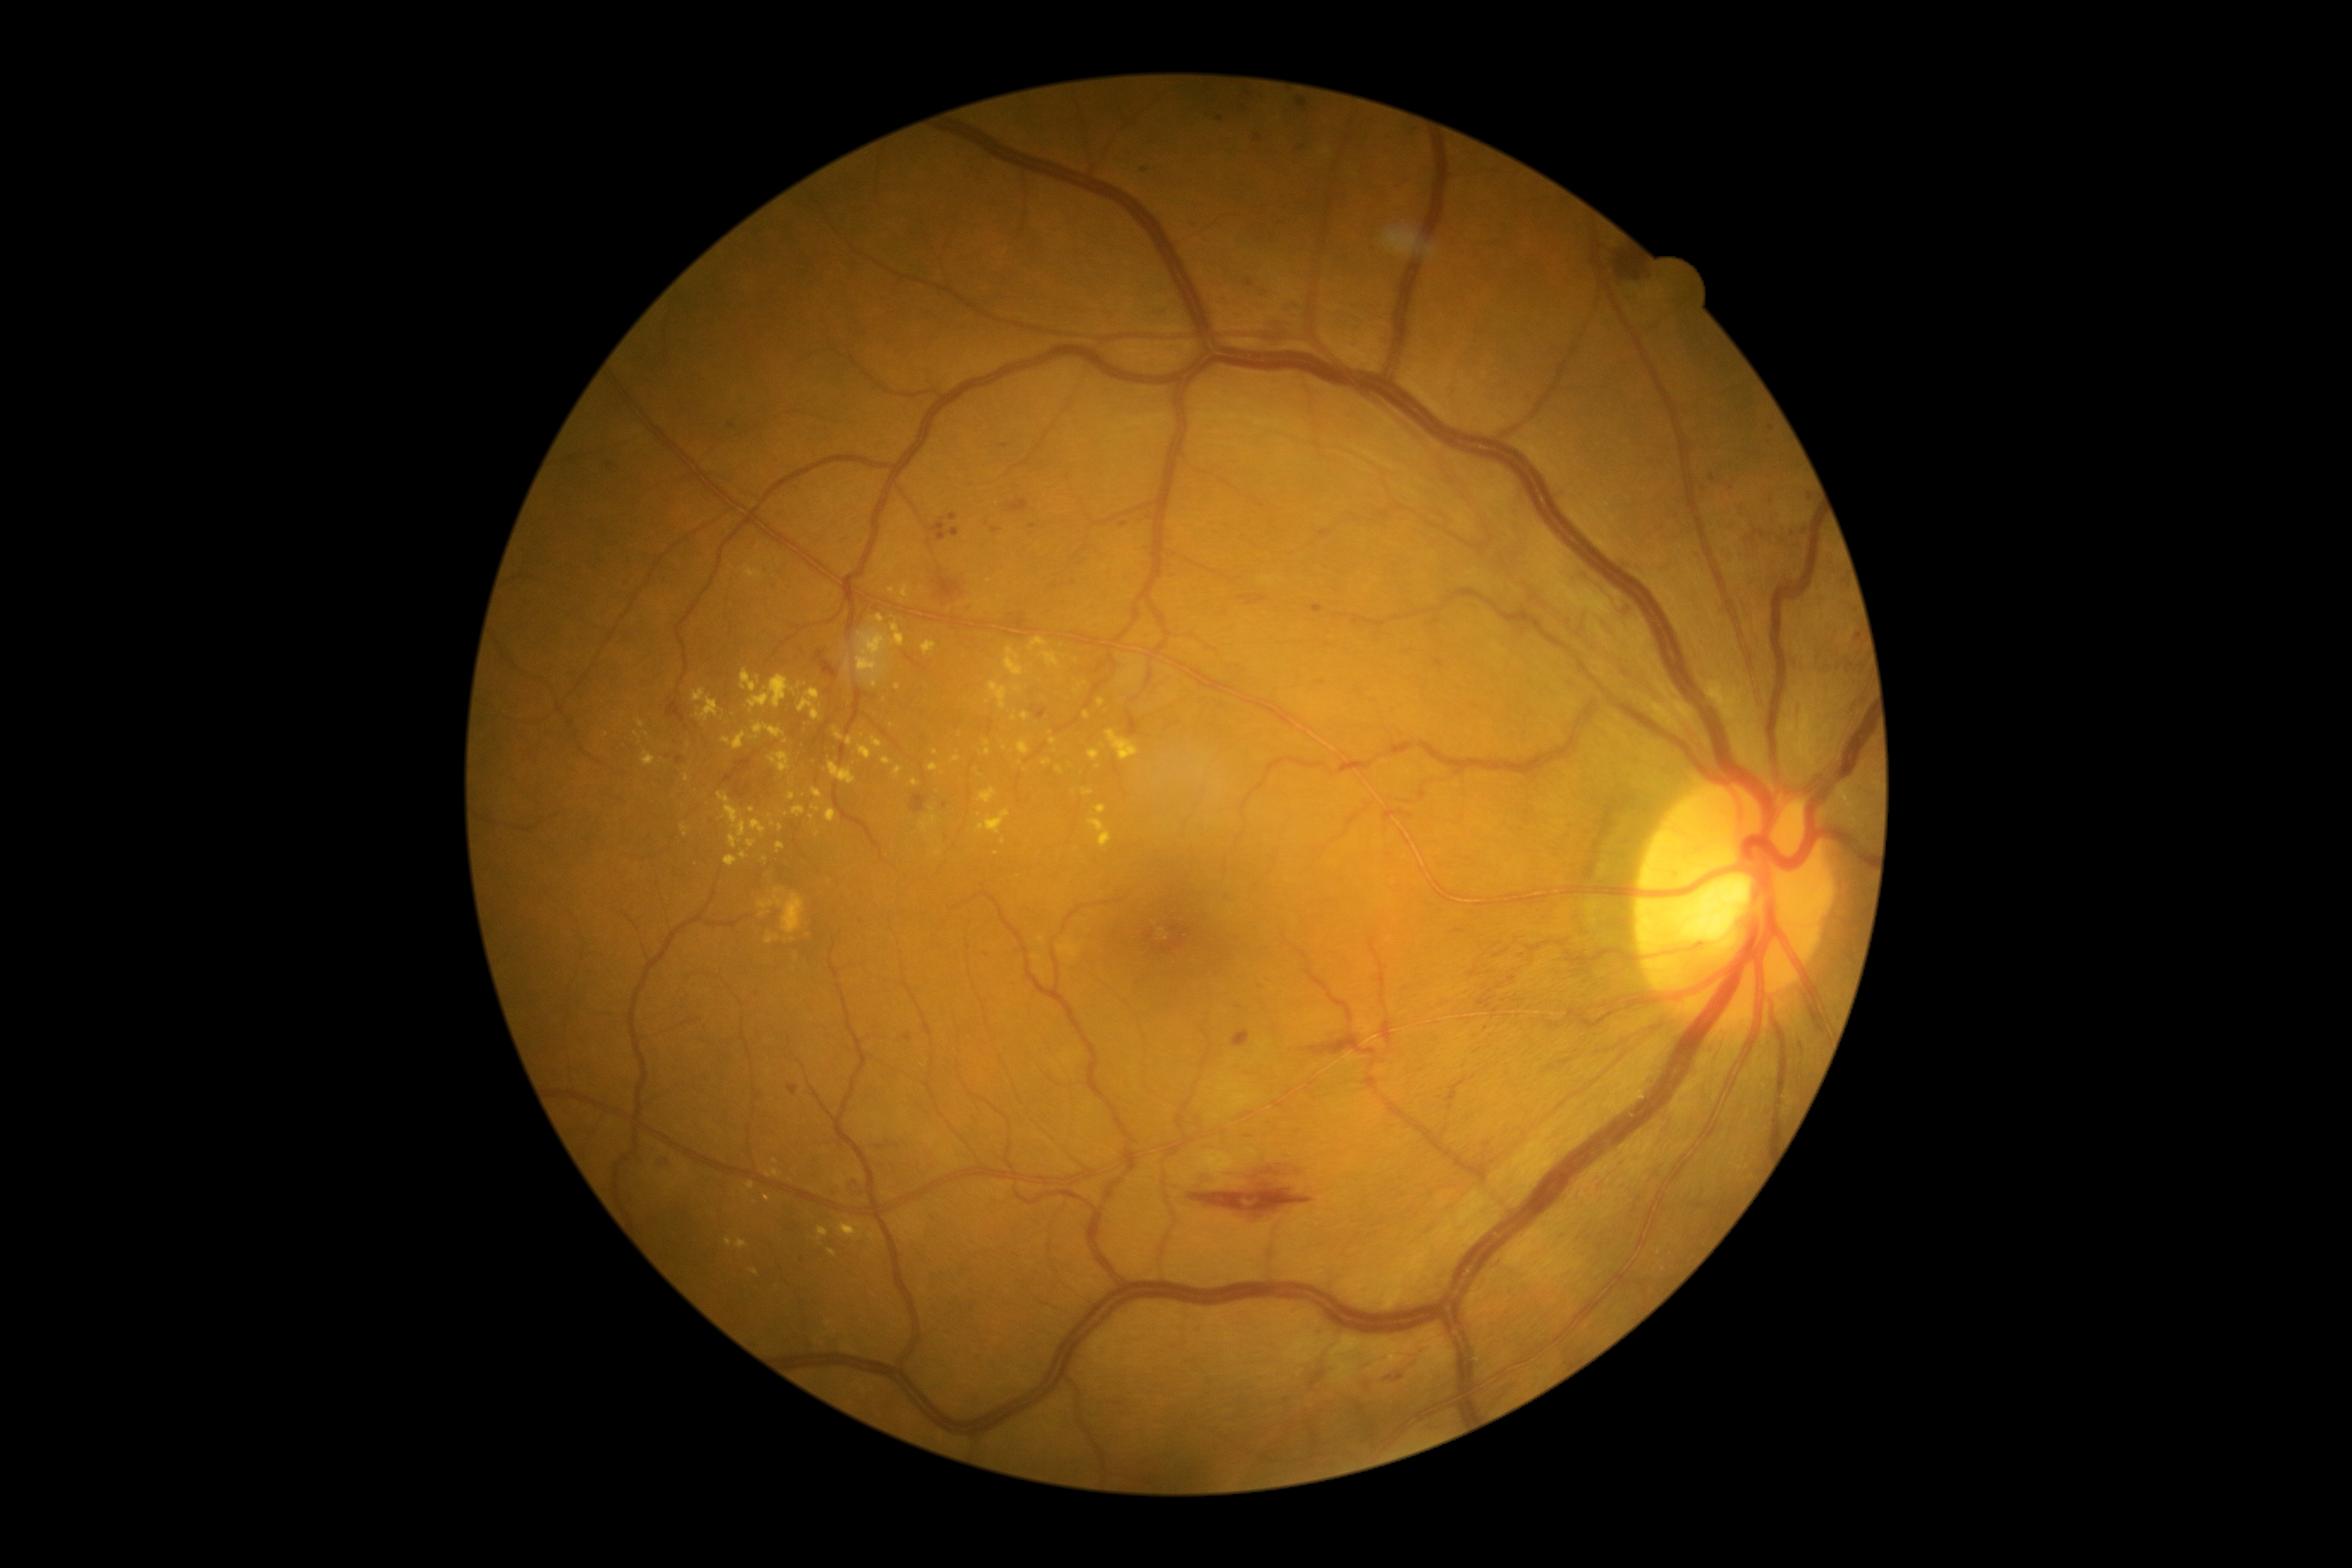
Retinopathy: grade 2 (moderate NPDR)
A subset of detected lesions:
hard exudates (subset): [989, 682, 1008, 709]; [692, 689, 720, 723]; [749, 1268, 759, 1275]; [737, 1239, 749, 1249]; [1043, 761, 1051, 766]; [929, 764, 940, 773]; [859, 745, 873, 761]; [787, 793, 795, 800]; [835, 728, 843, 740]; [792, 805, 805, 818]; [838, 1223, 864, 1239]; [1038, 936, 1044, 945]
Small hard exudates approximately at (1125,683); (960,735); (987,743); (887,547); (1131,680); (845,574); (647,734)